130° field of view (Clarity RetCam 3). Infant wide-field retinal image. Image size 640x480
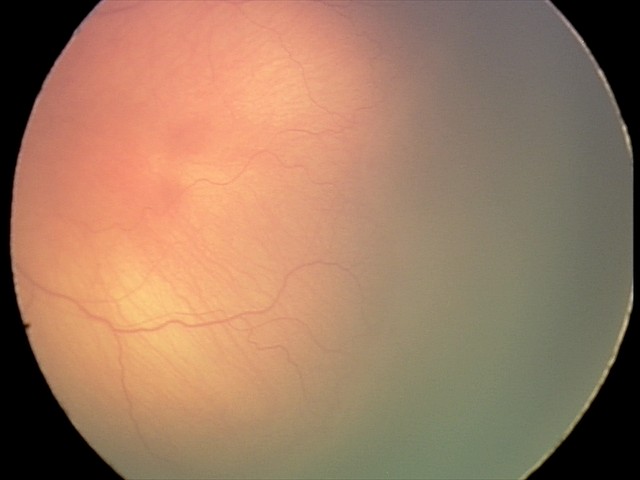

Screening examination consistent with retinopathy of prematurity stage 1.